Color fundus image; centered on the optic disc; captured on a Topcon TRC-NW400 fundus camera; non-mydriatic; 2212x1661px:
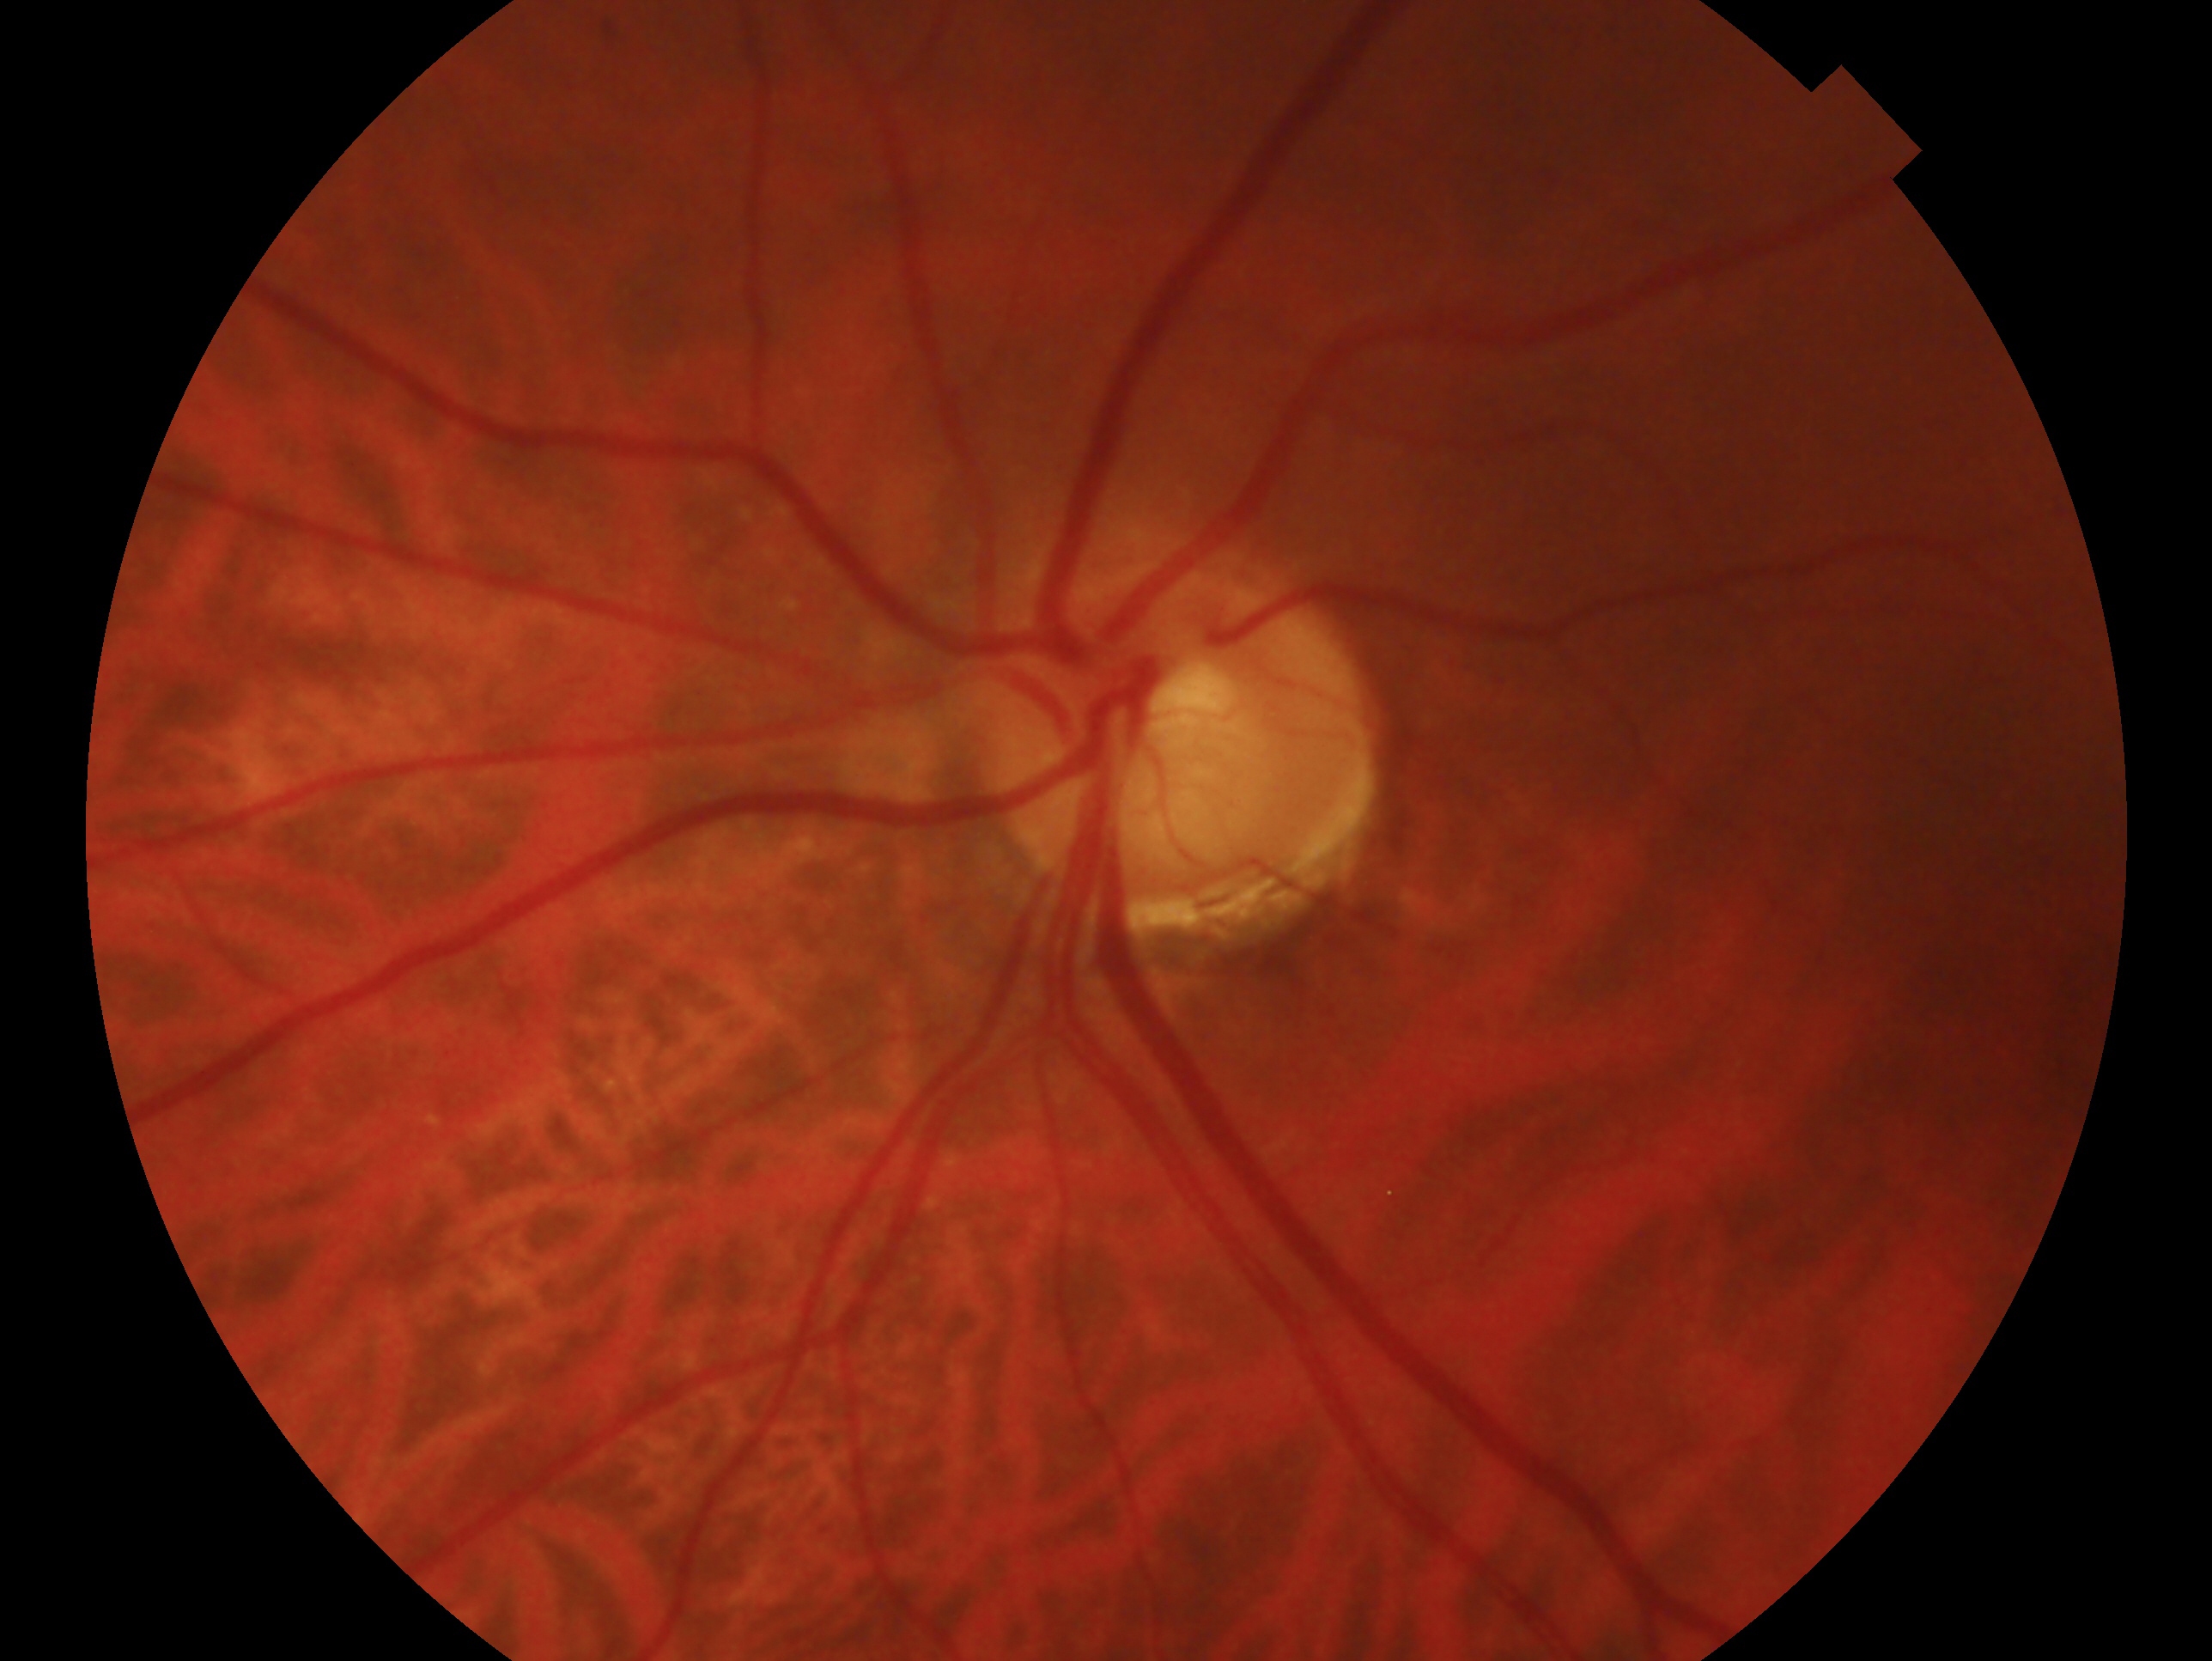

Diagnosis: suspected glaucoma — risk factors or equivocal findings for glaucoma without a confirmed diagnosis.
Imaged eye: left eye.